DR severity per modified Davis staging.
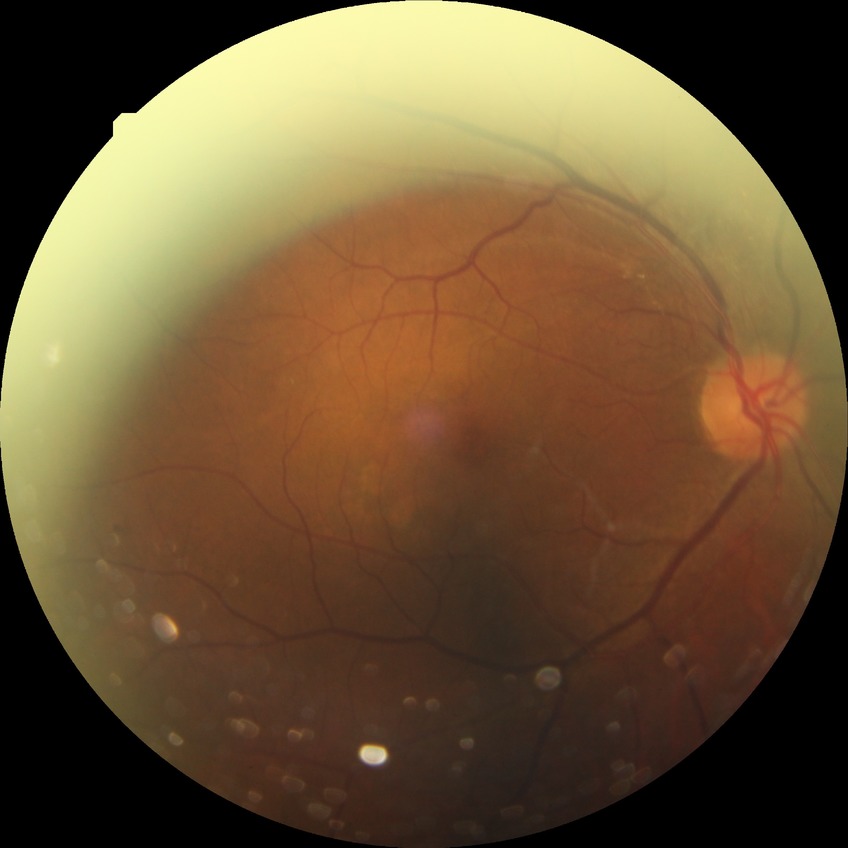 Findings:
– modified Davis grading: simple diabetic retinopathy